45° field of view; image size 848x848; diabetic retinopathy graded by the modified Davis classification — 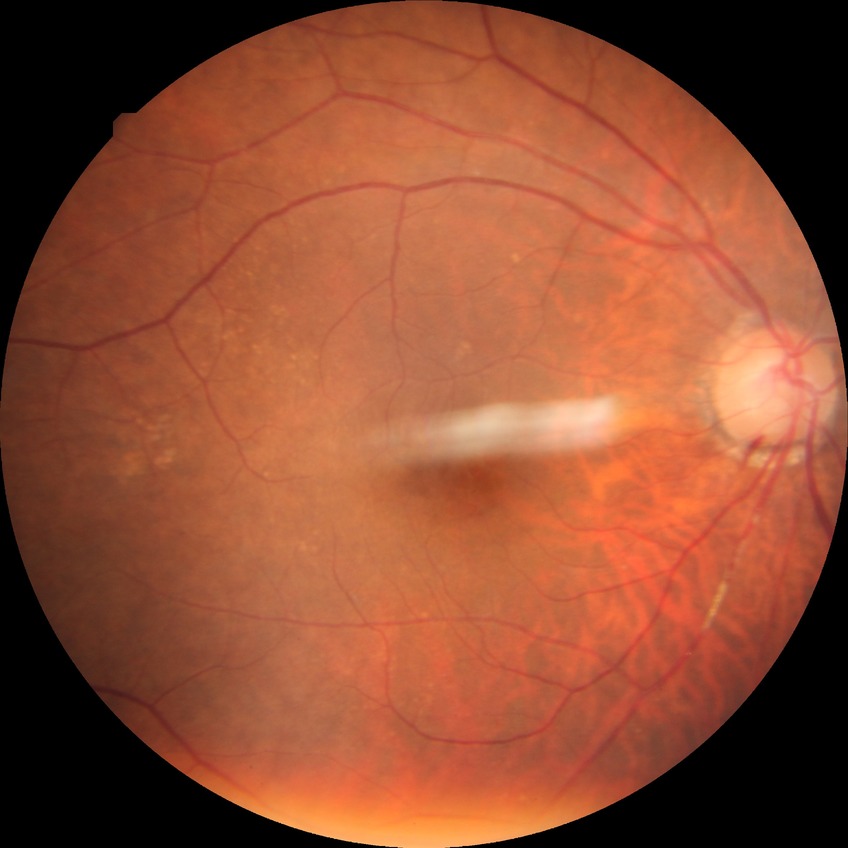   davis_grade: NDR (no diabetic retinopathy)